NIDEK AFC-230 — 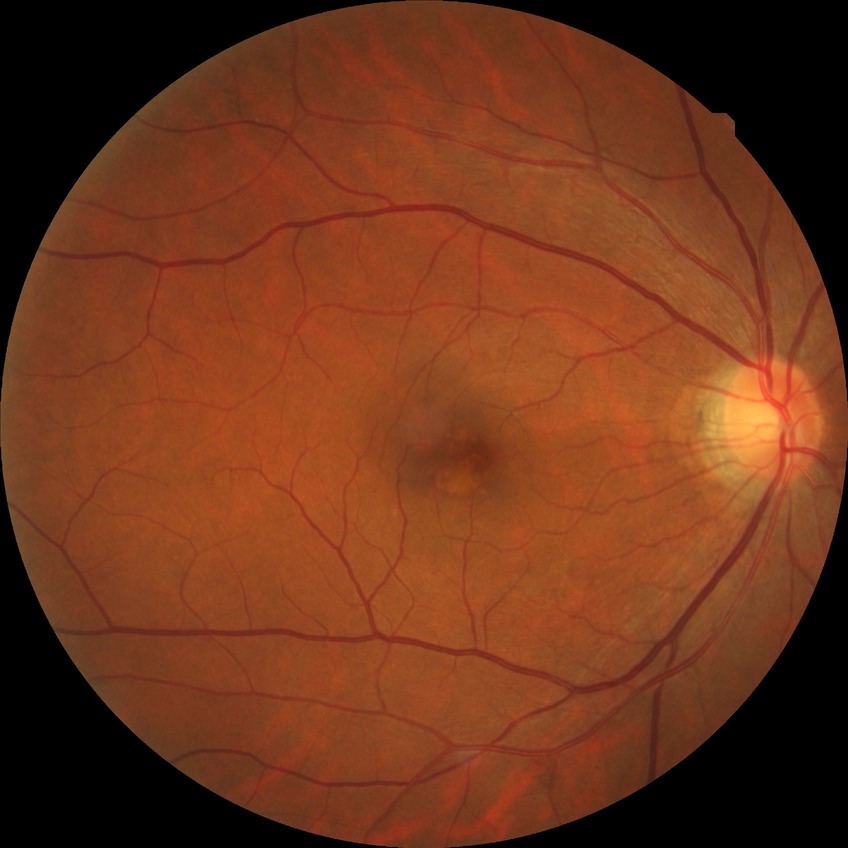
{"davis_grade": "NDR (no diabetic retinopathy)"}